2352 x 1568 pixels
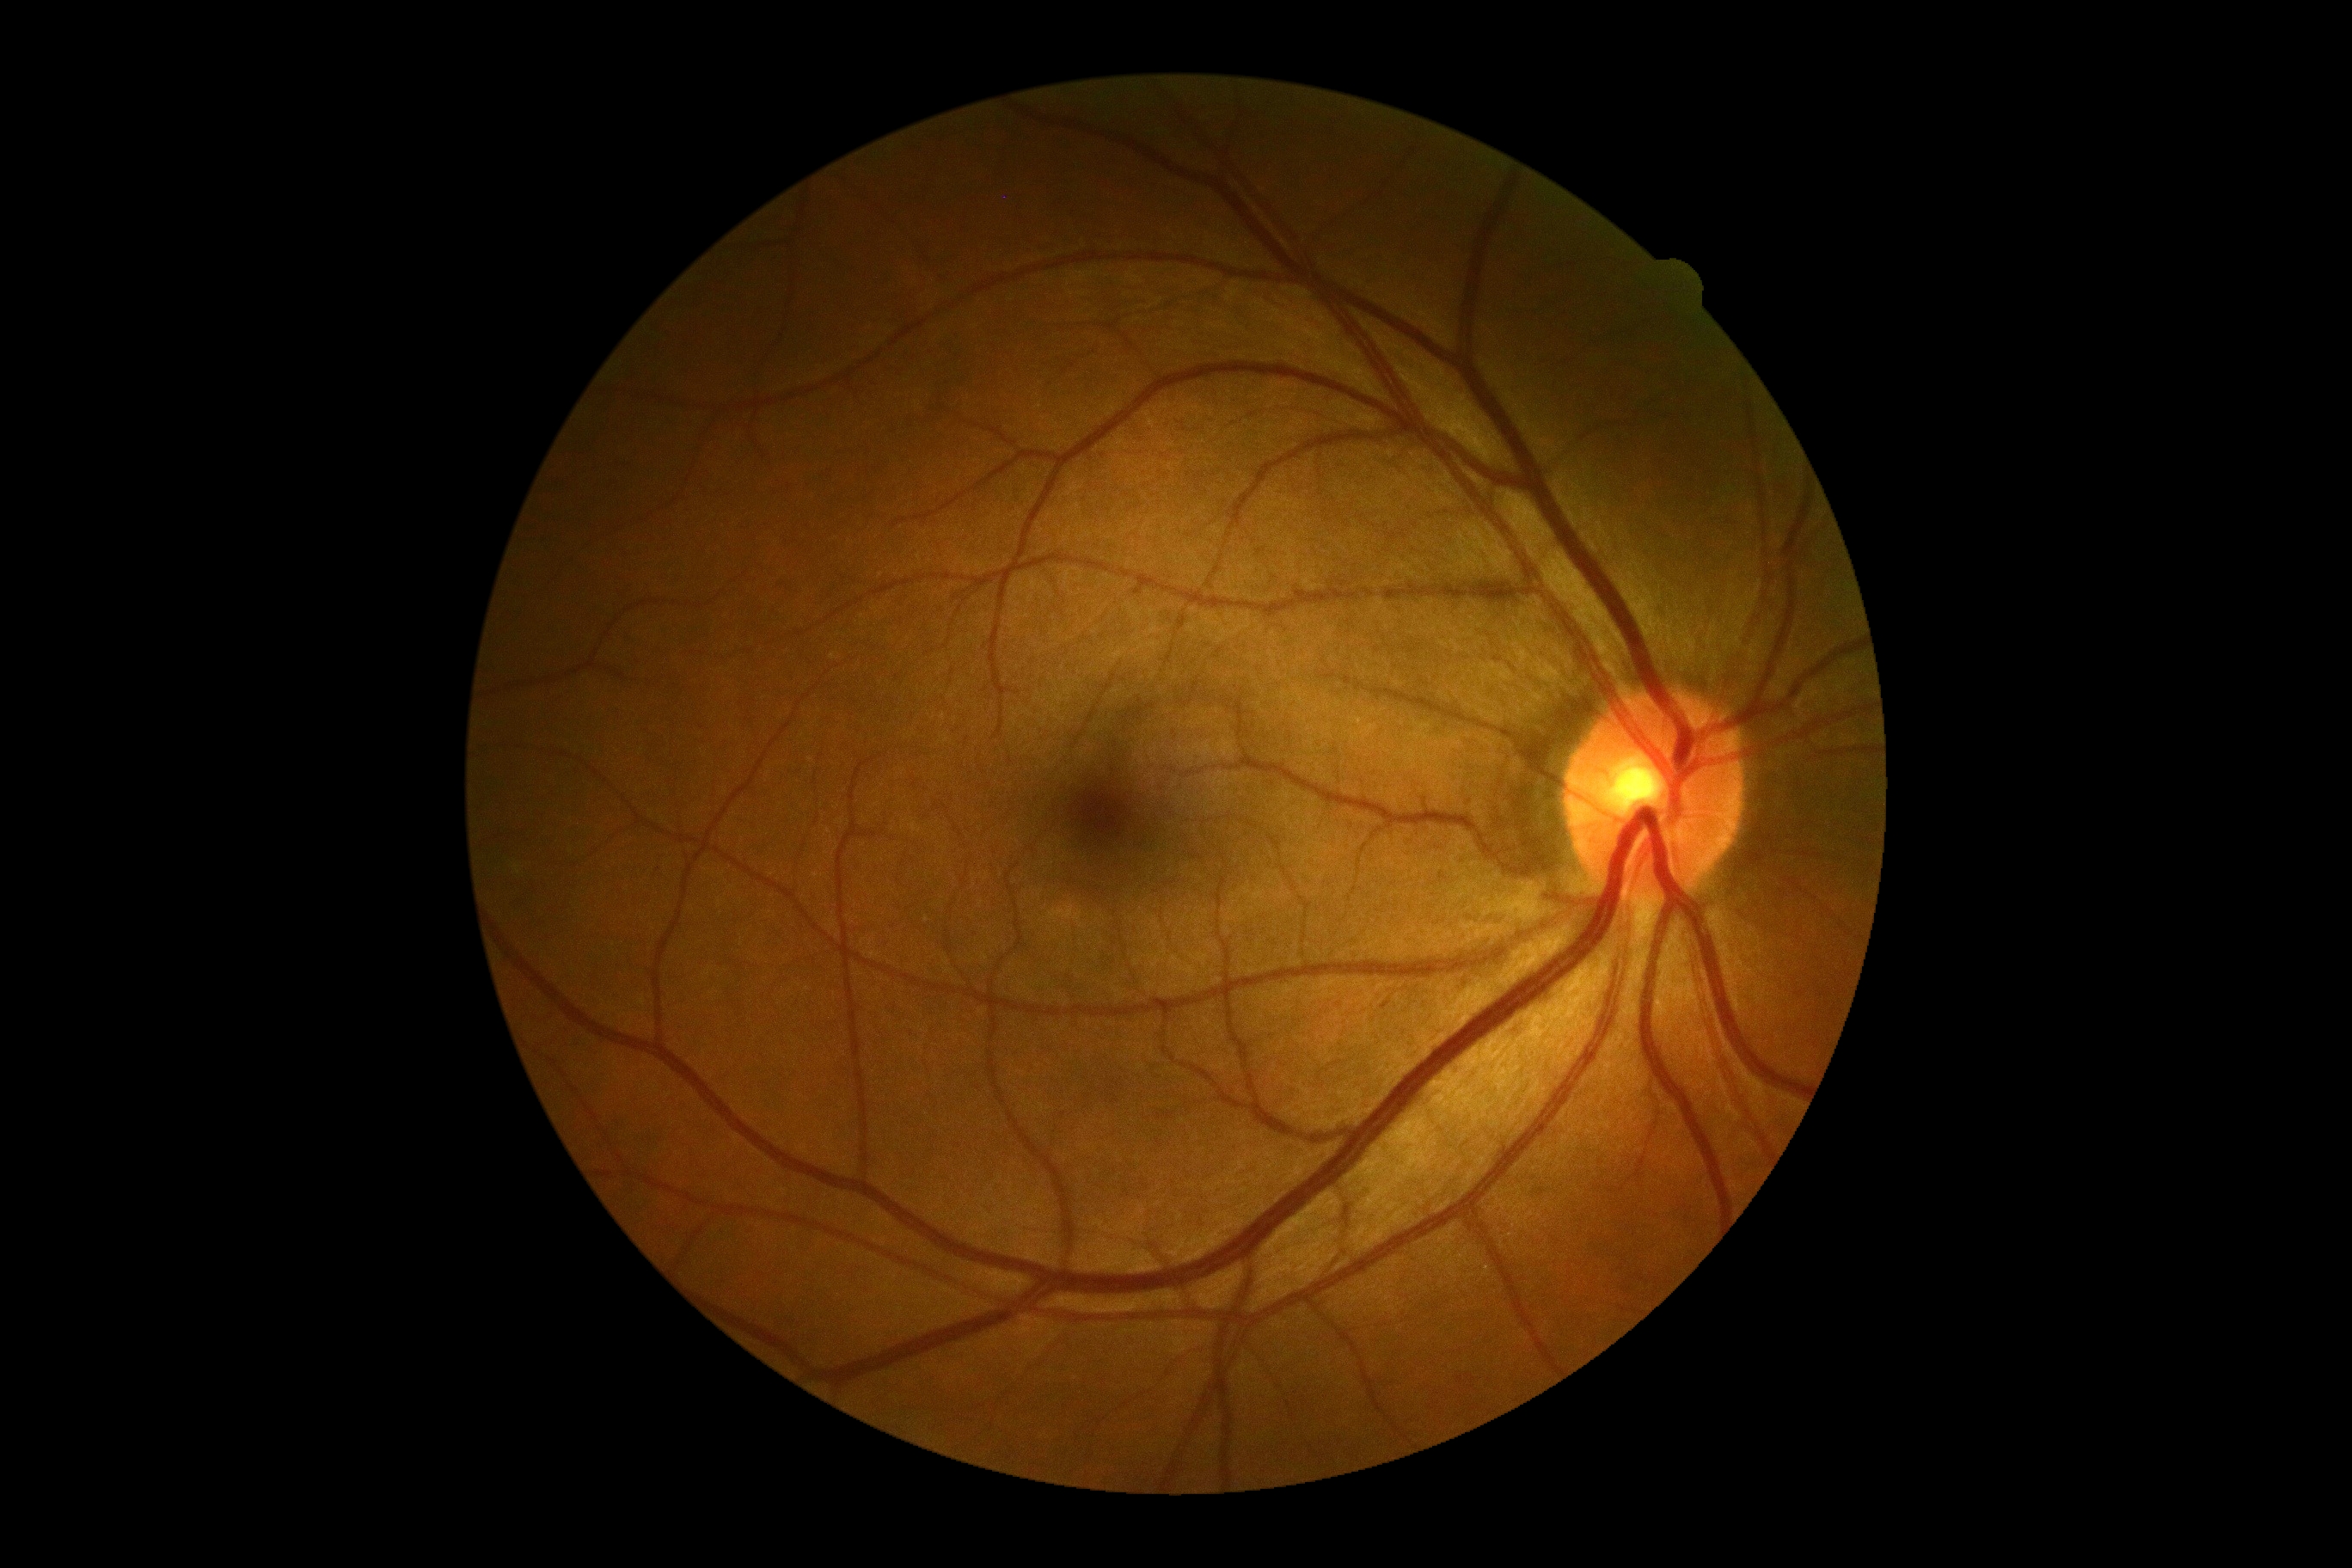
DR severity is no apparent retinopathy (grade 0).